Acquired with a NIDEK AFC-230.
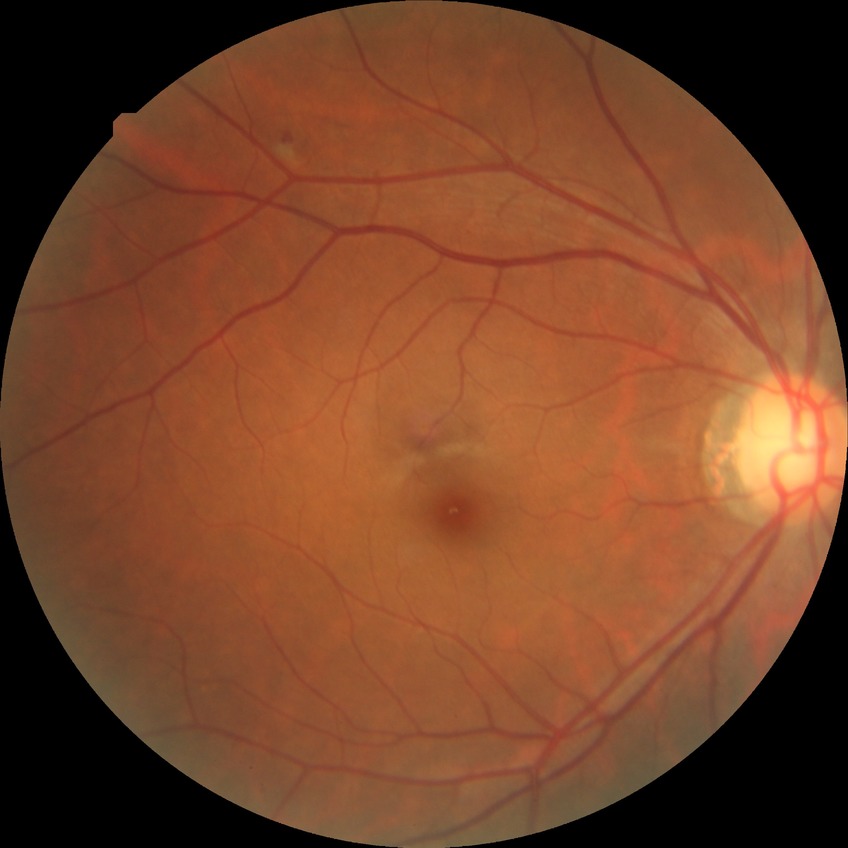 Diabetic retinopathy (DR) is simple diabetic retinopathy (SDR).